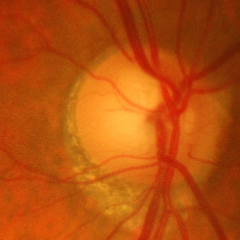
Findings consistent with advanced-stage glaucoma.